Phoenix ICON, 100° FOV; wide-field fundus image from infant ROP screening; 1240 by 1240 pixels
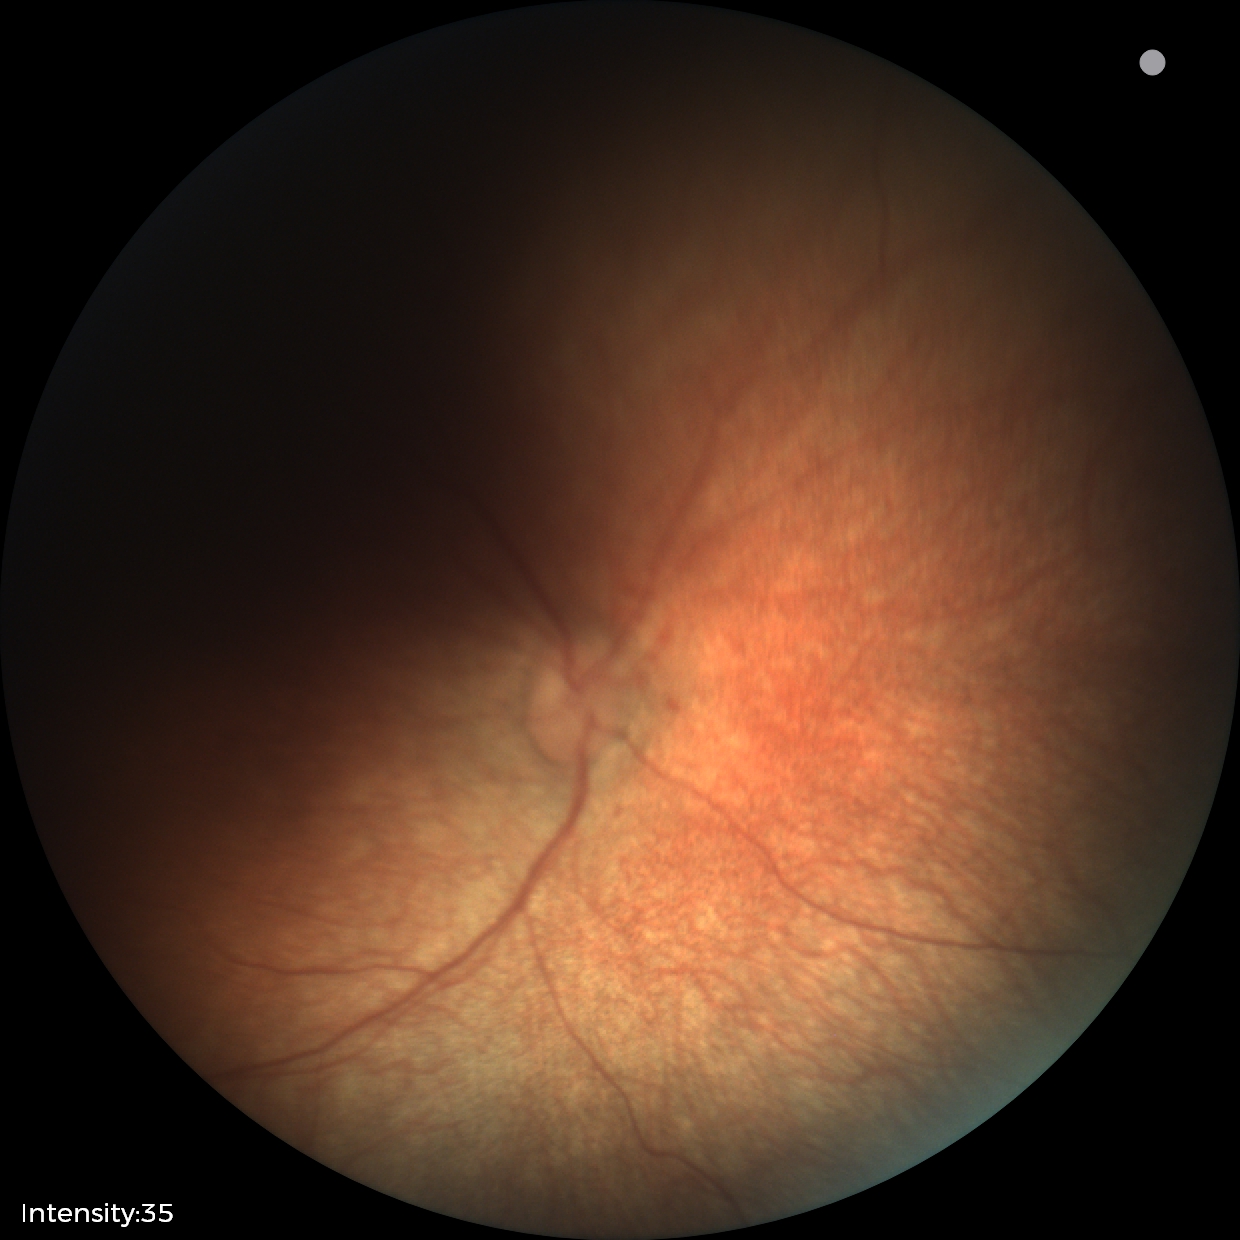

Finding: normal